Nonmydriatic fundus photograph: 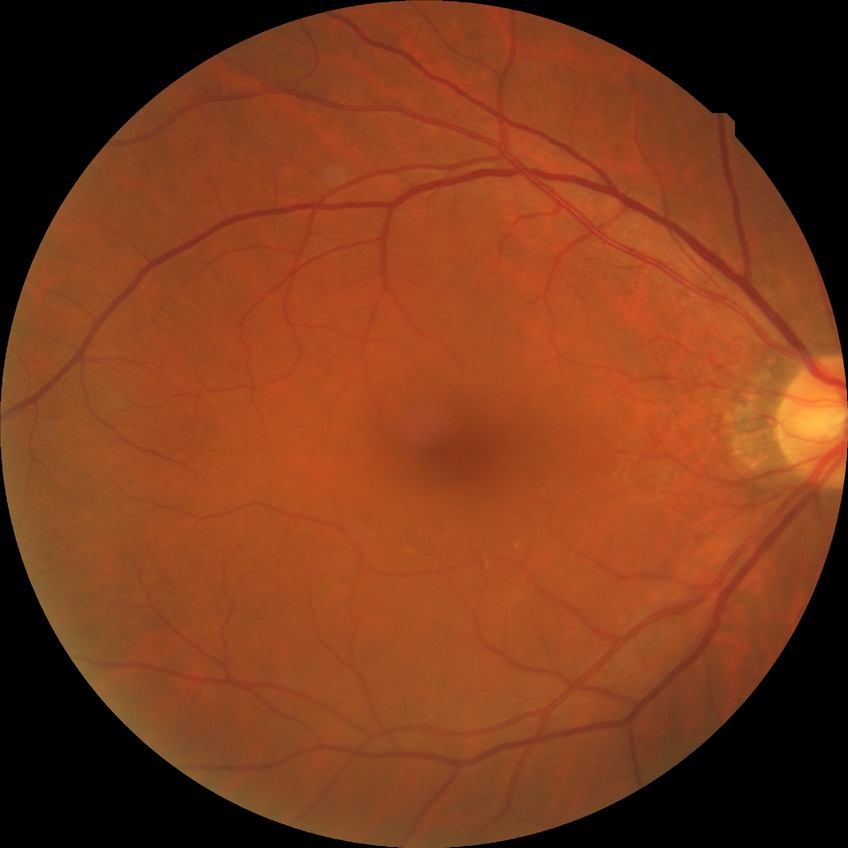
Findings:
– DR — NDR
– DR impression — no signs of DR